DR severity per modified Davis staging — 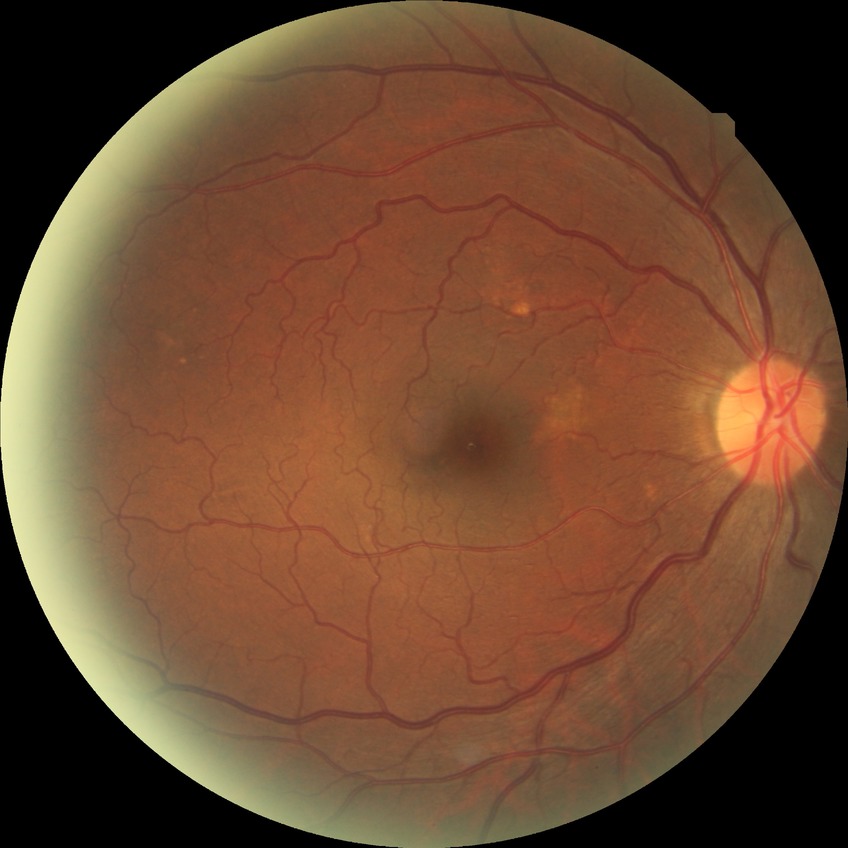

modified Davis classification@no diabetic retinopathy.